Image size 640x480; wide-field fundus photograph from neonatal ROP screening
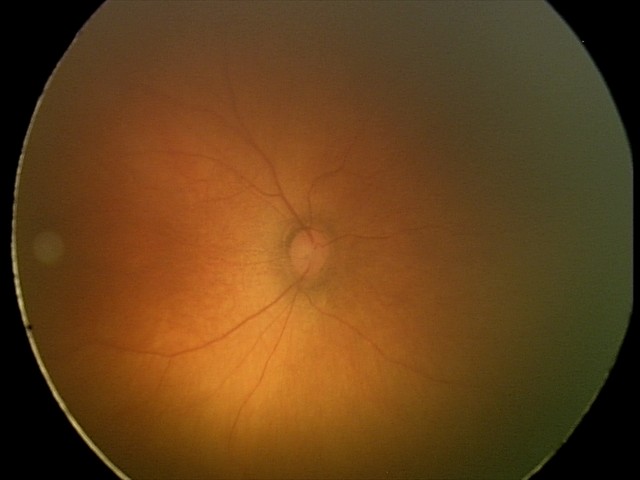 Screening examination diagnosed as physiological.